1932x1910px: 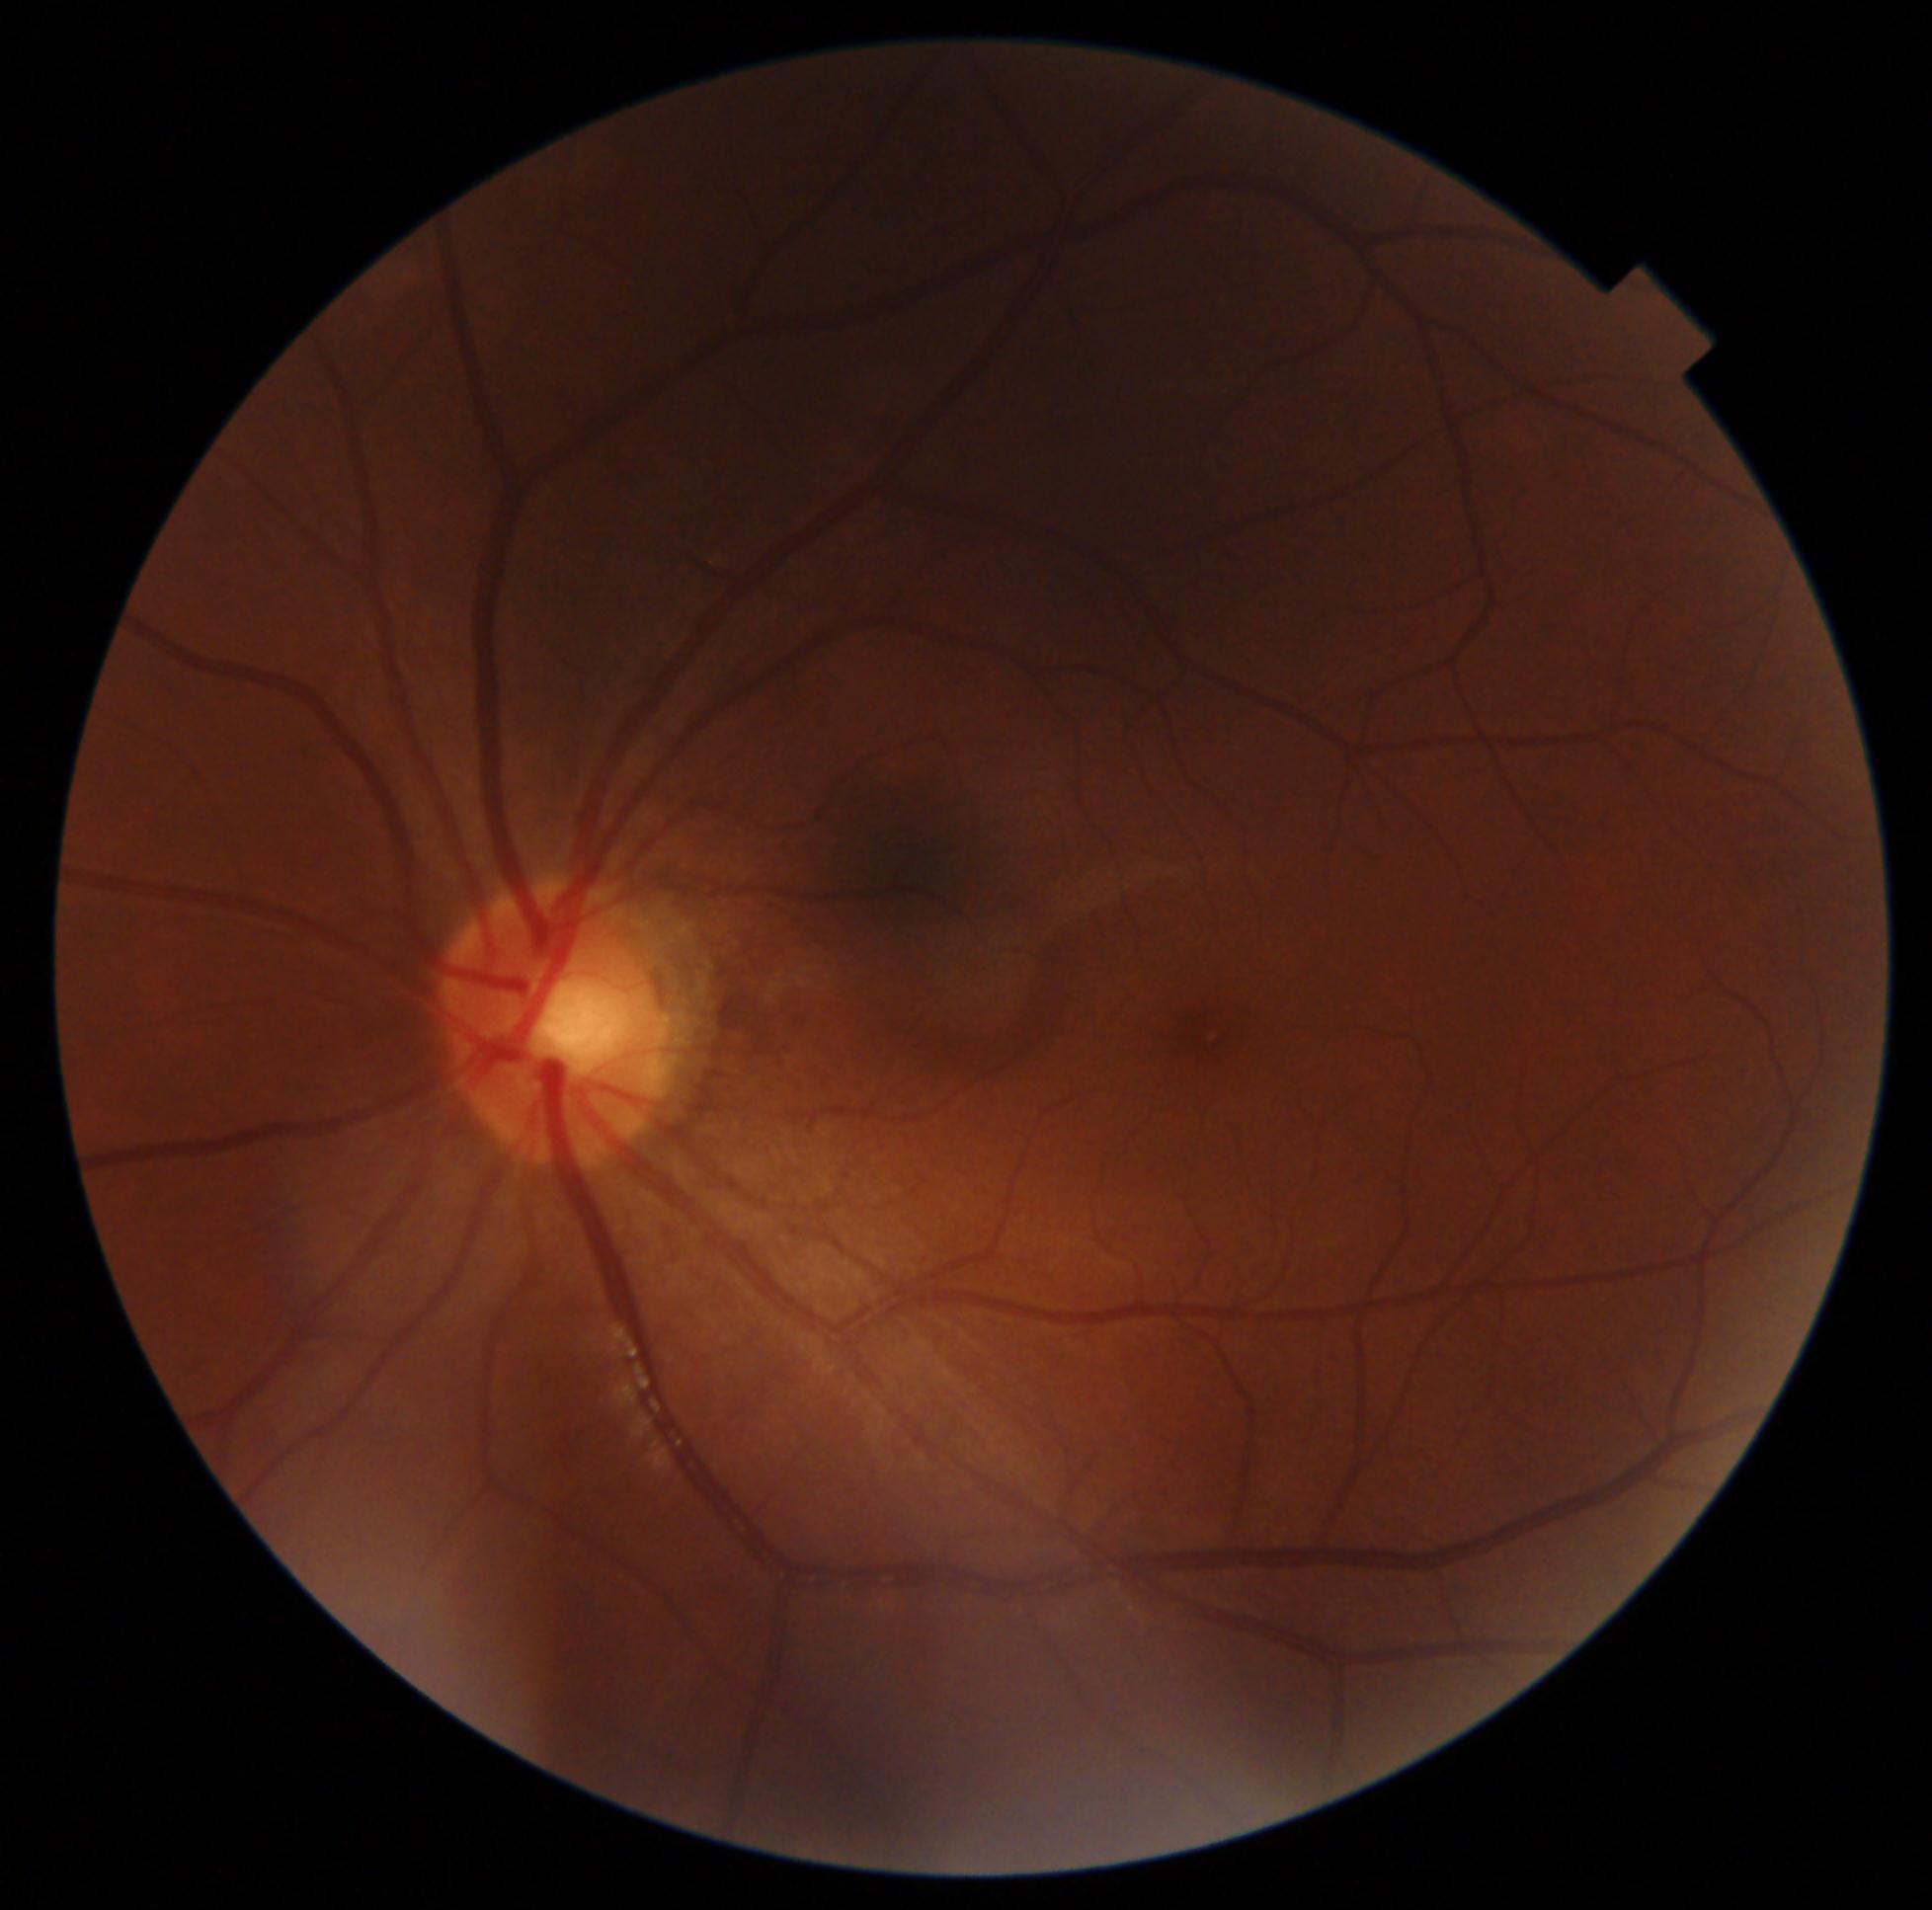
  dr_grade: grade 0 (no apparent retinopathy) — no visible signs of diabetic retinopathy